Topcon TRC fundus camera, ONH-centered crop from a color fundus image — 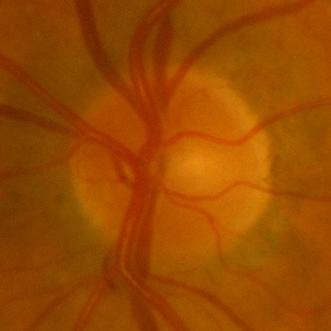
Showing no signs of glaucoma.